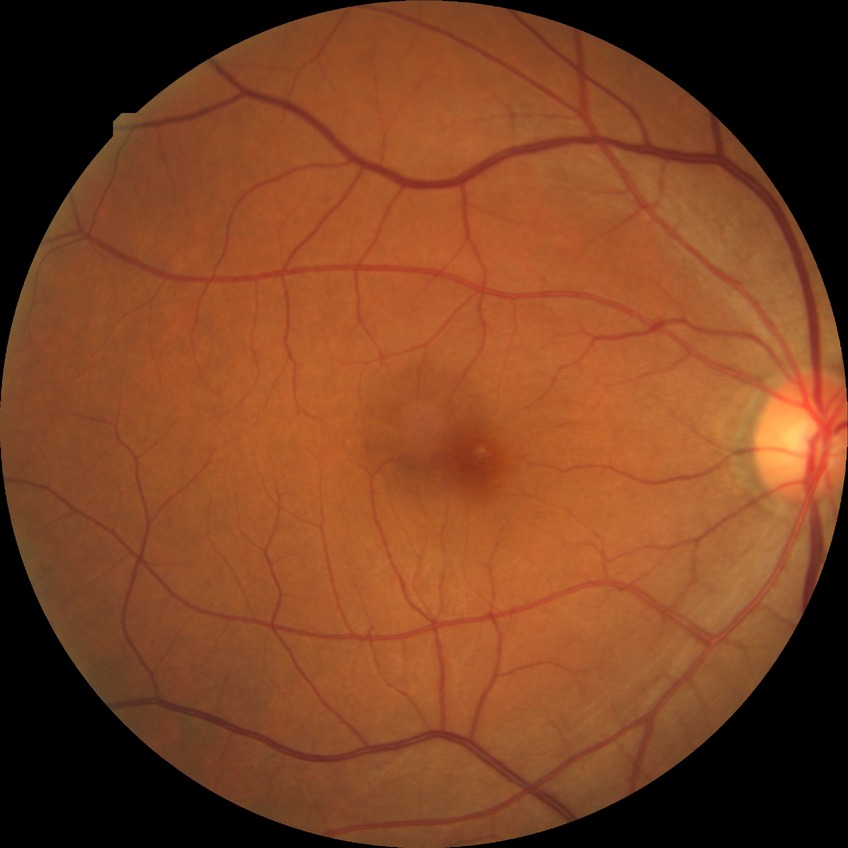
Diabetic retinopathy (DR) is NDR (no diabetic retinopathy).